848 x 848 pixels.
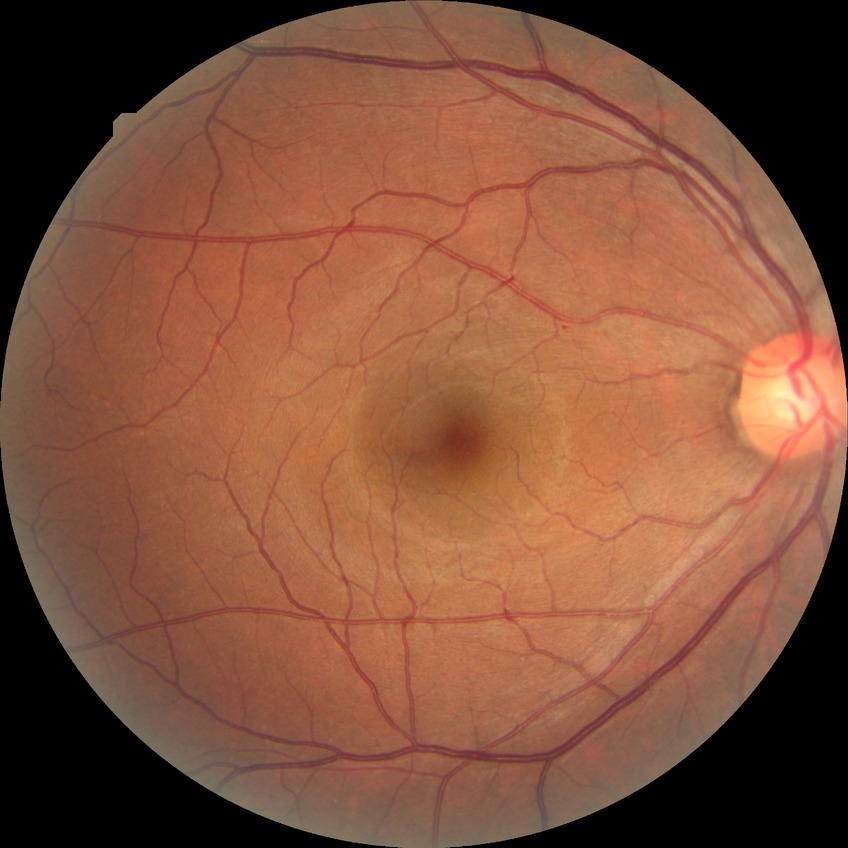 Diabetic retinopathy stage is simple diabetic retinopathy. Disease class: non-proliferative diabetic retinopathy.